Infant wide-field fundus photograph · camera: Phoenix ICON (100° FOV)
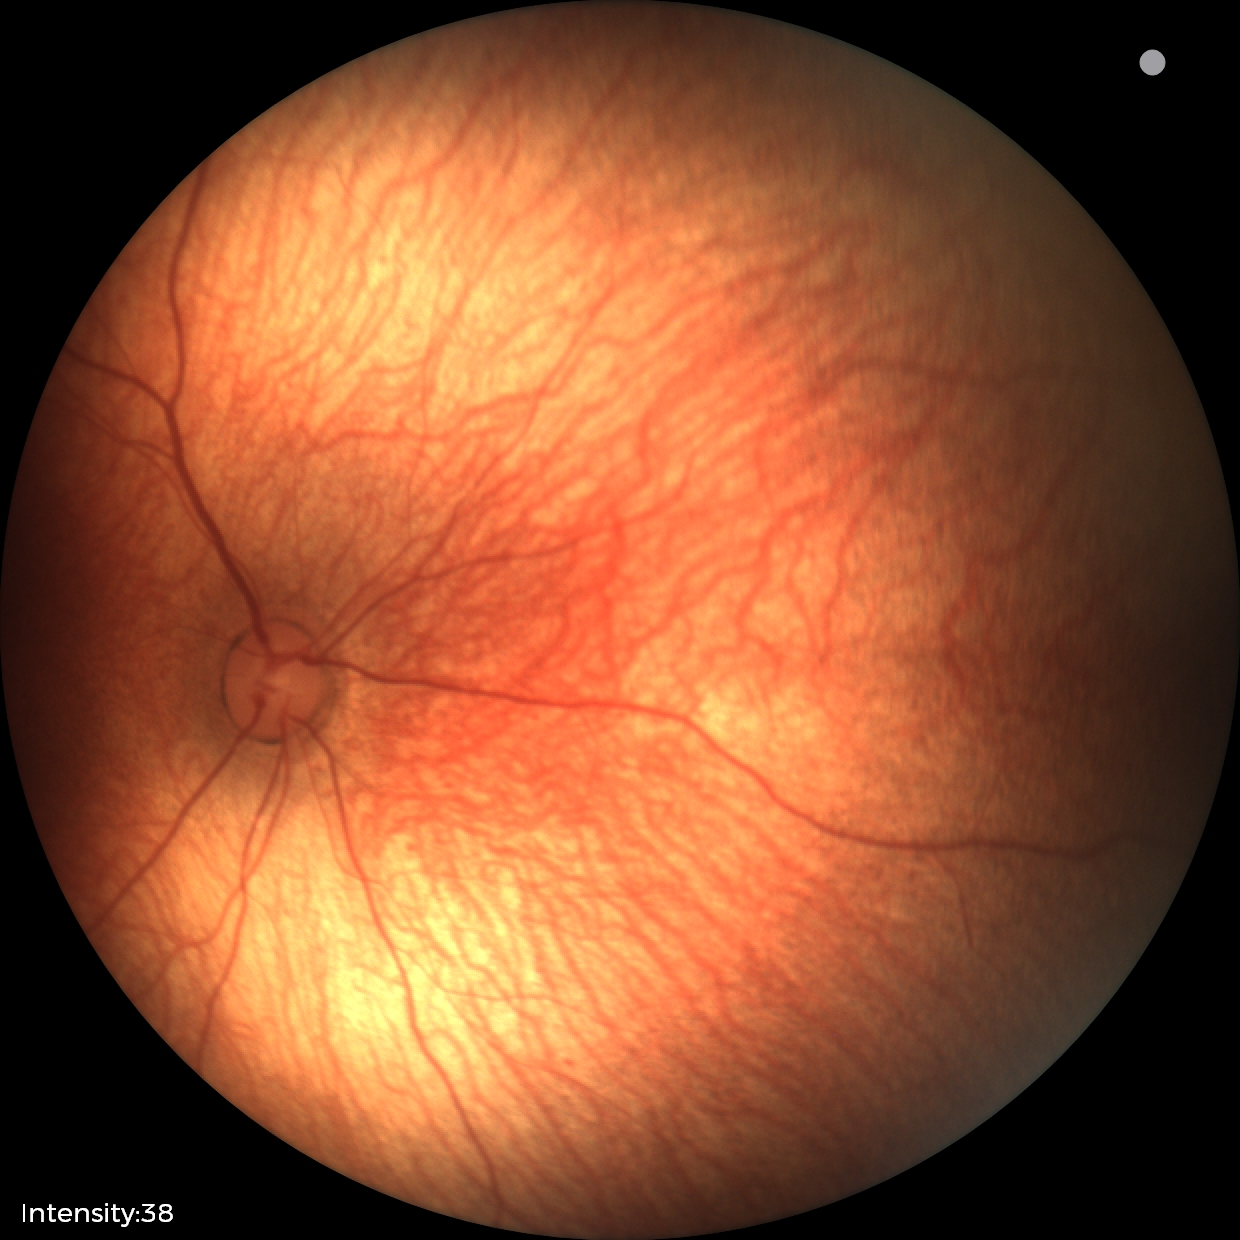 Assessment: normal retinal appearance.